240x240px.
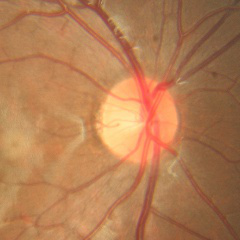 Showing no glaucomatous changes.